45-degree field of view:
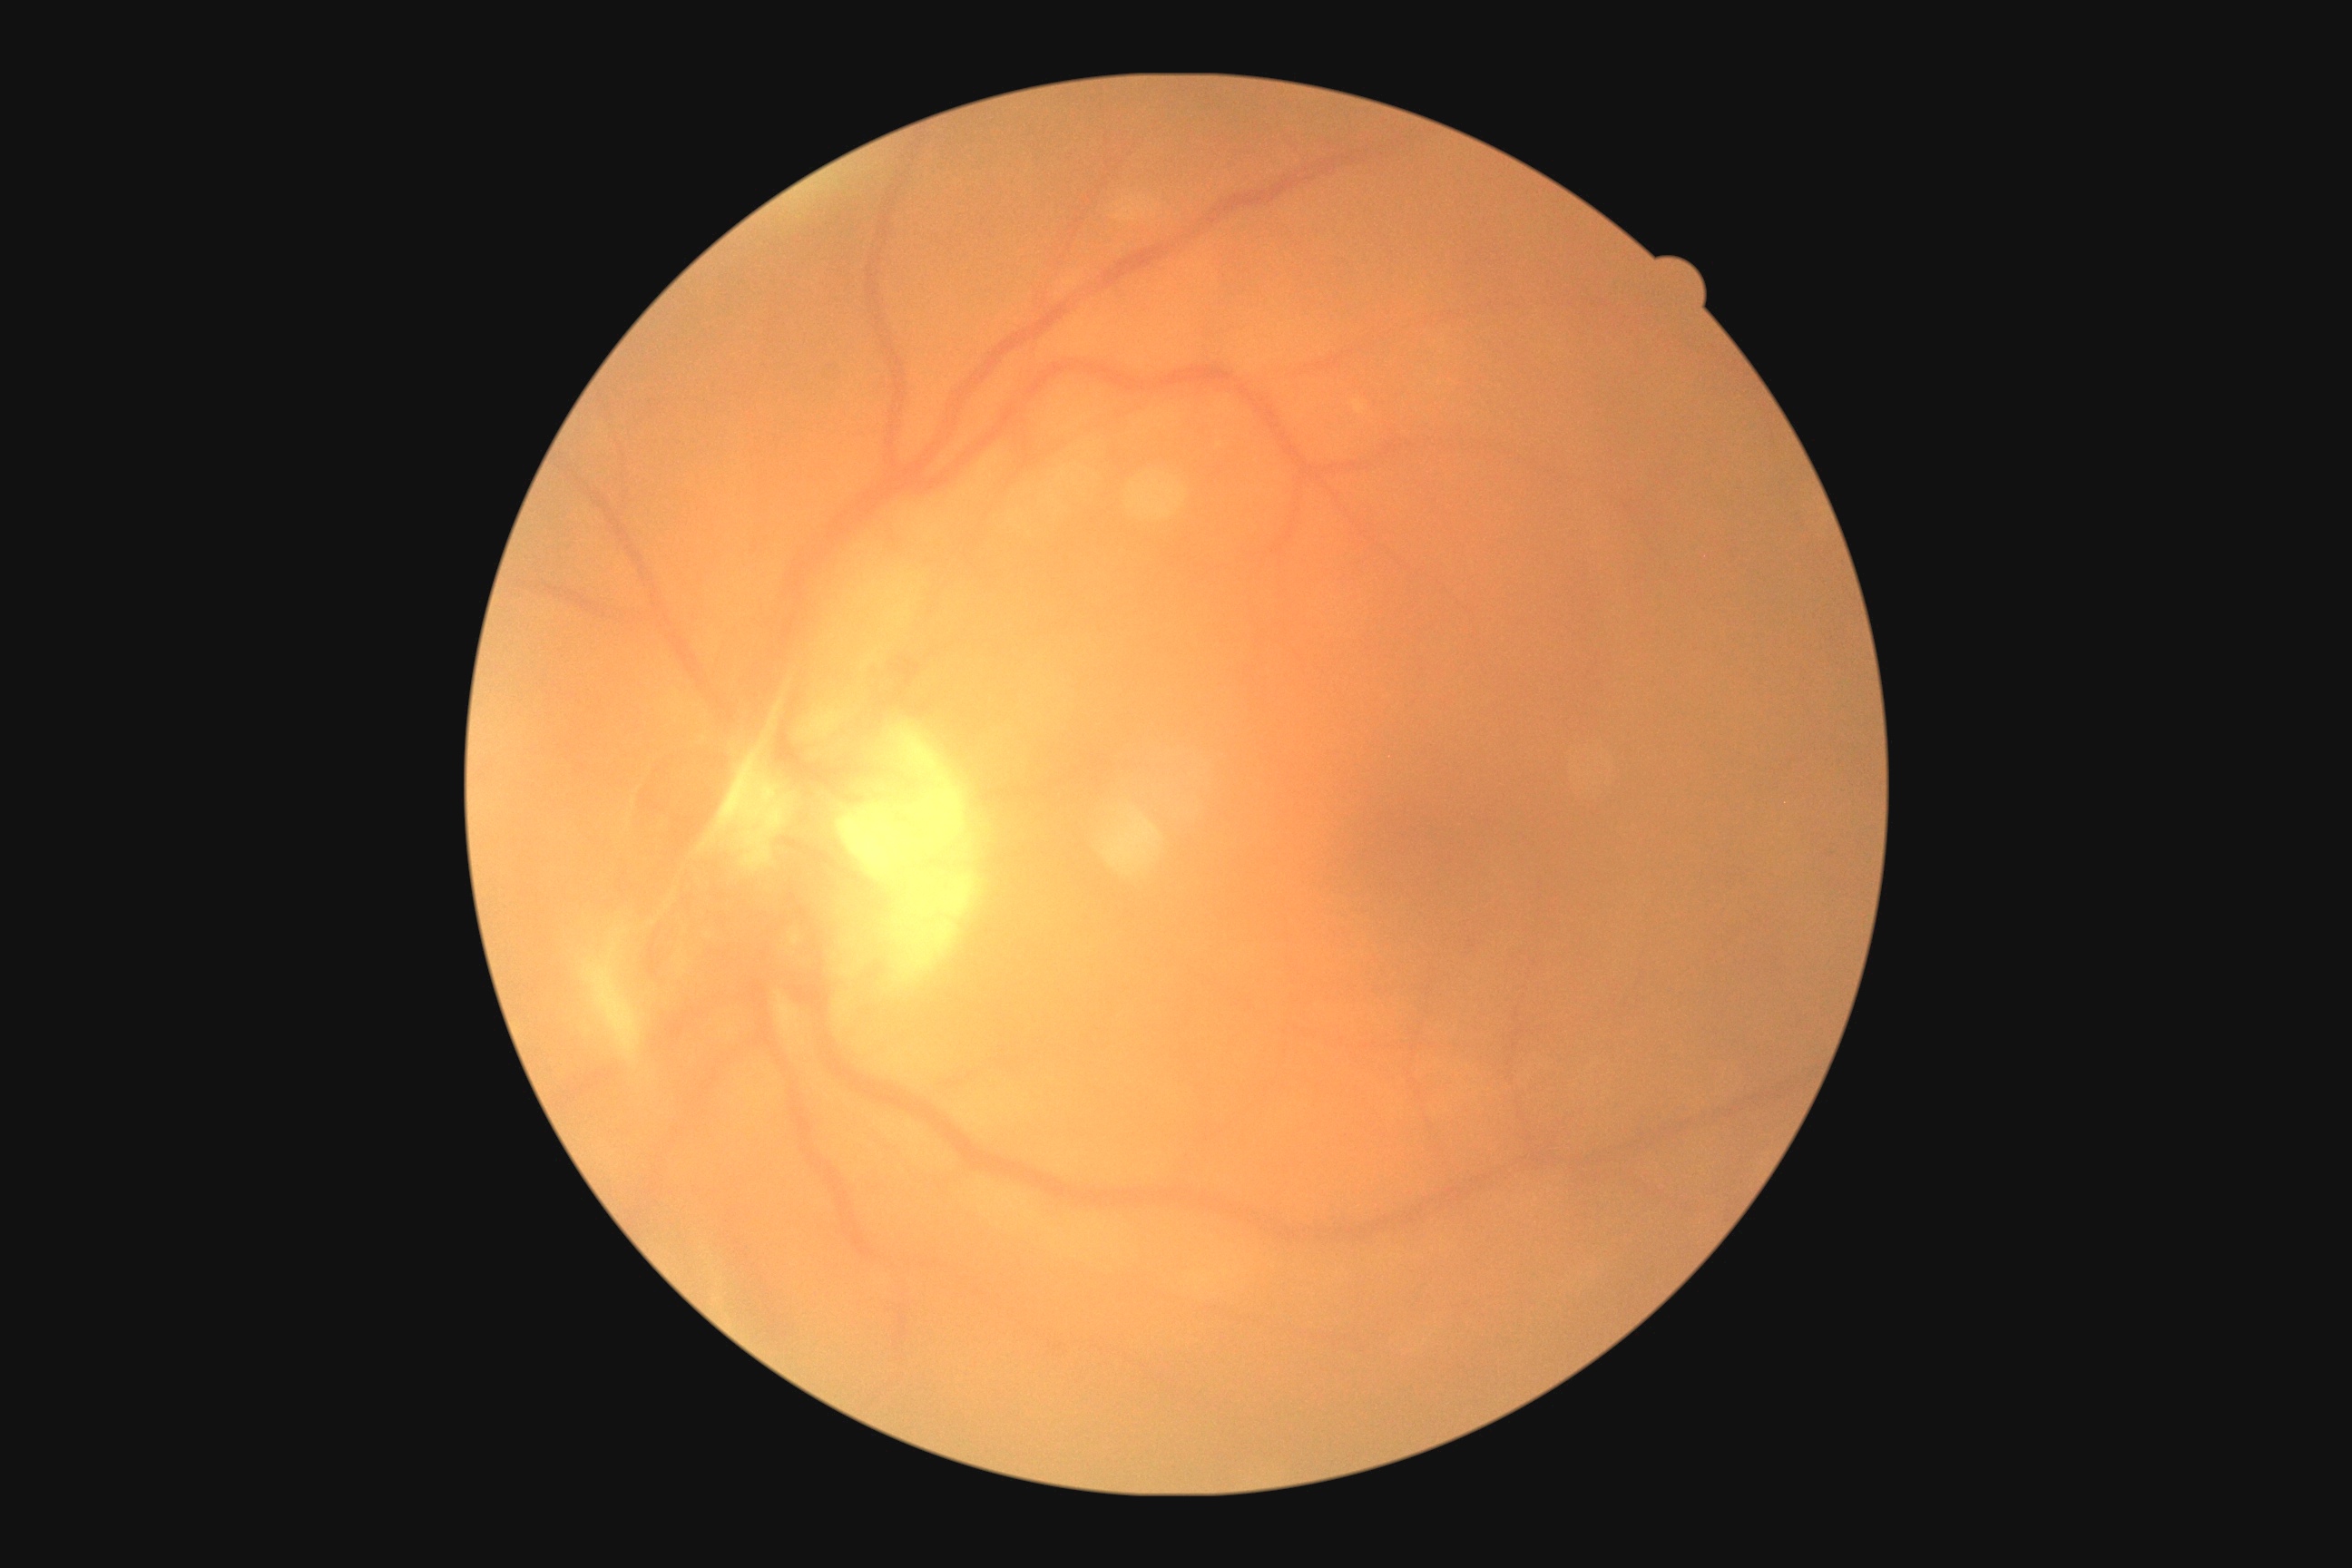 * DR class: proliferative diabetic retinopathy
* diabetic retinopathy: 4/4